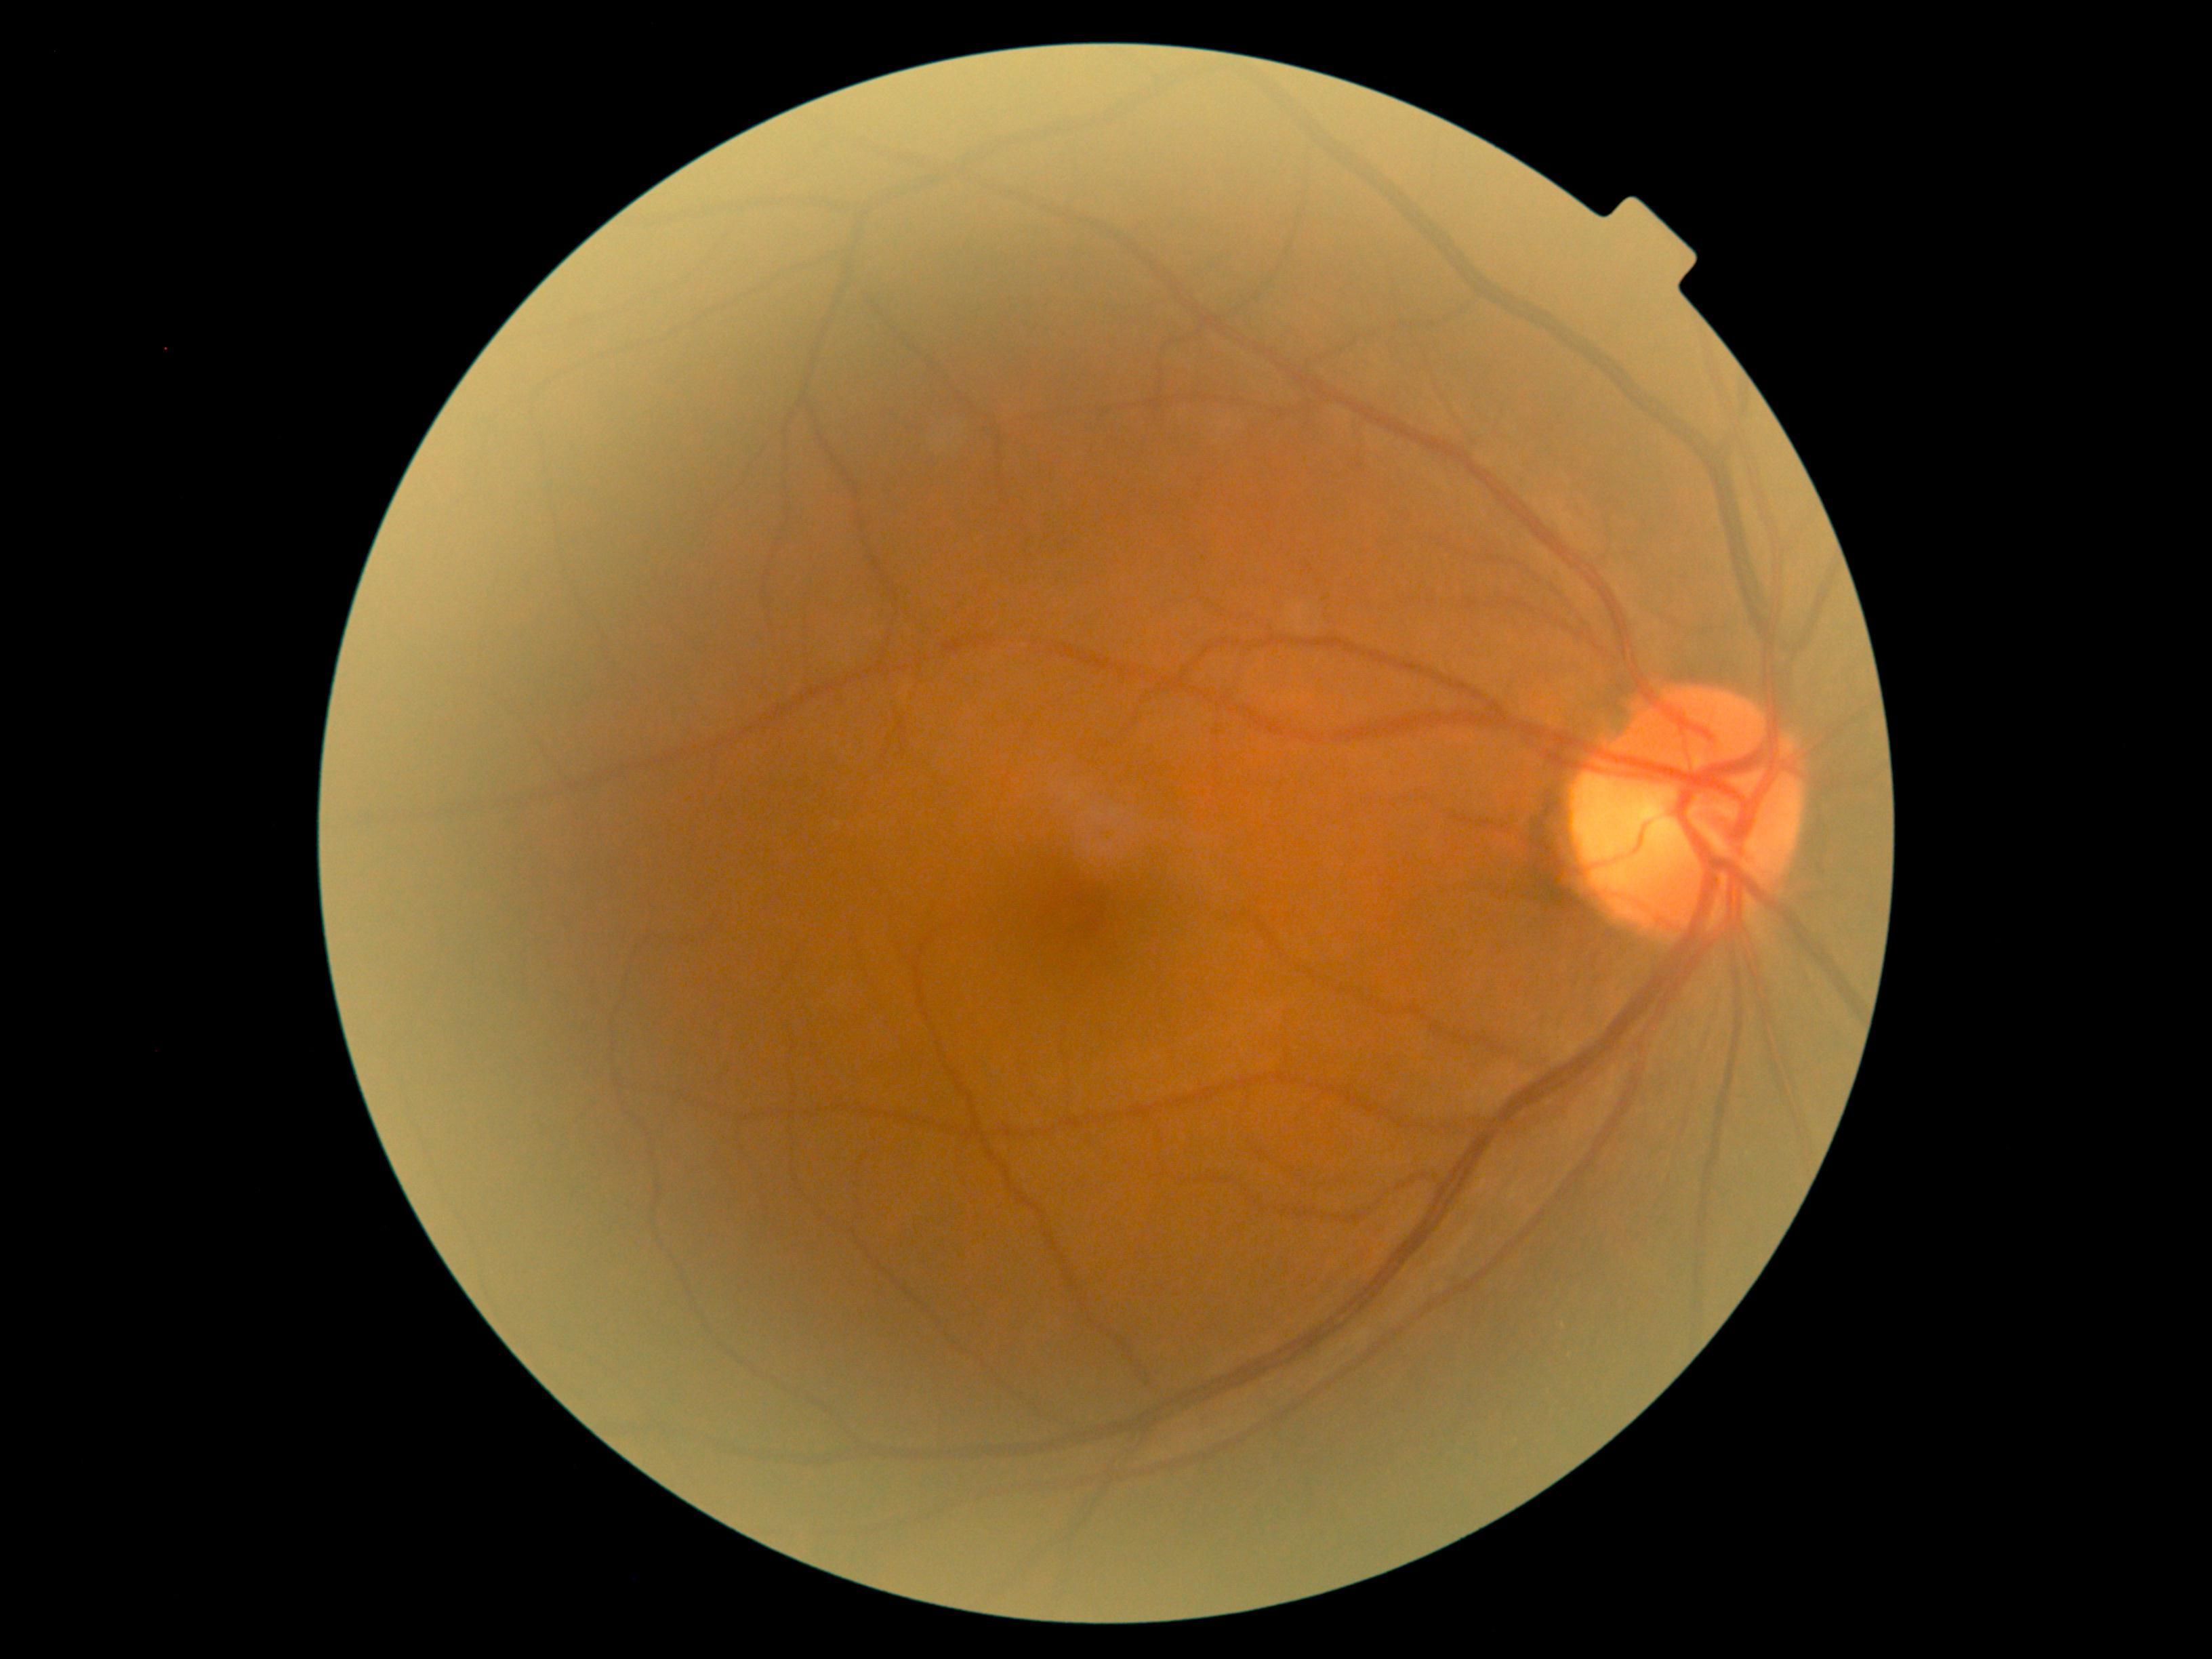 No diabetic retinal disease findings.
Retinopathy grade is no apparent diabetic retinopathy (0).